2212 by 1659 pixels; portable fundus photograph.
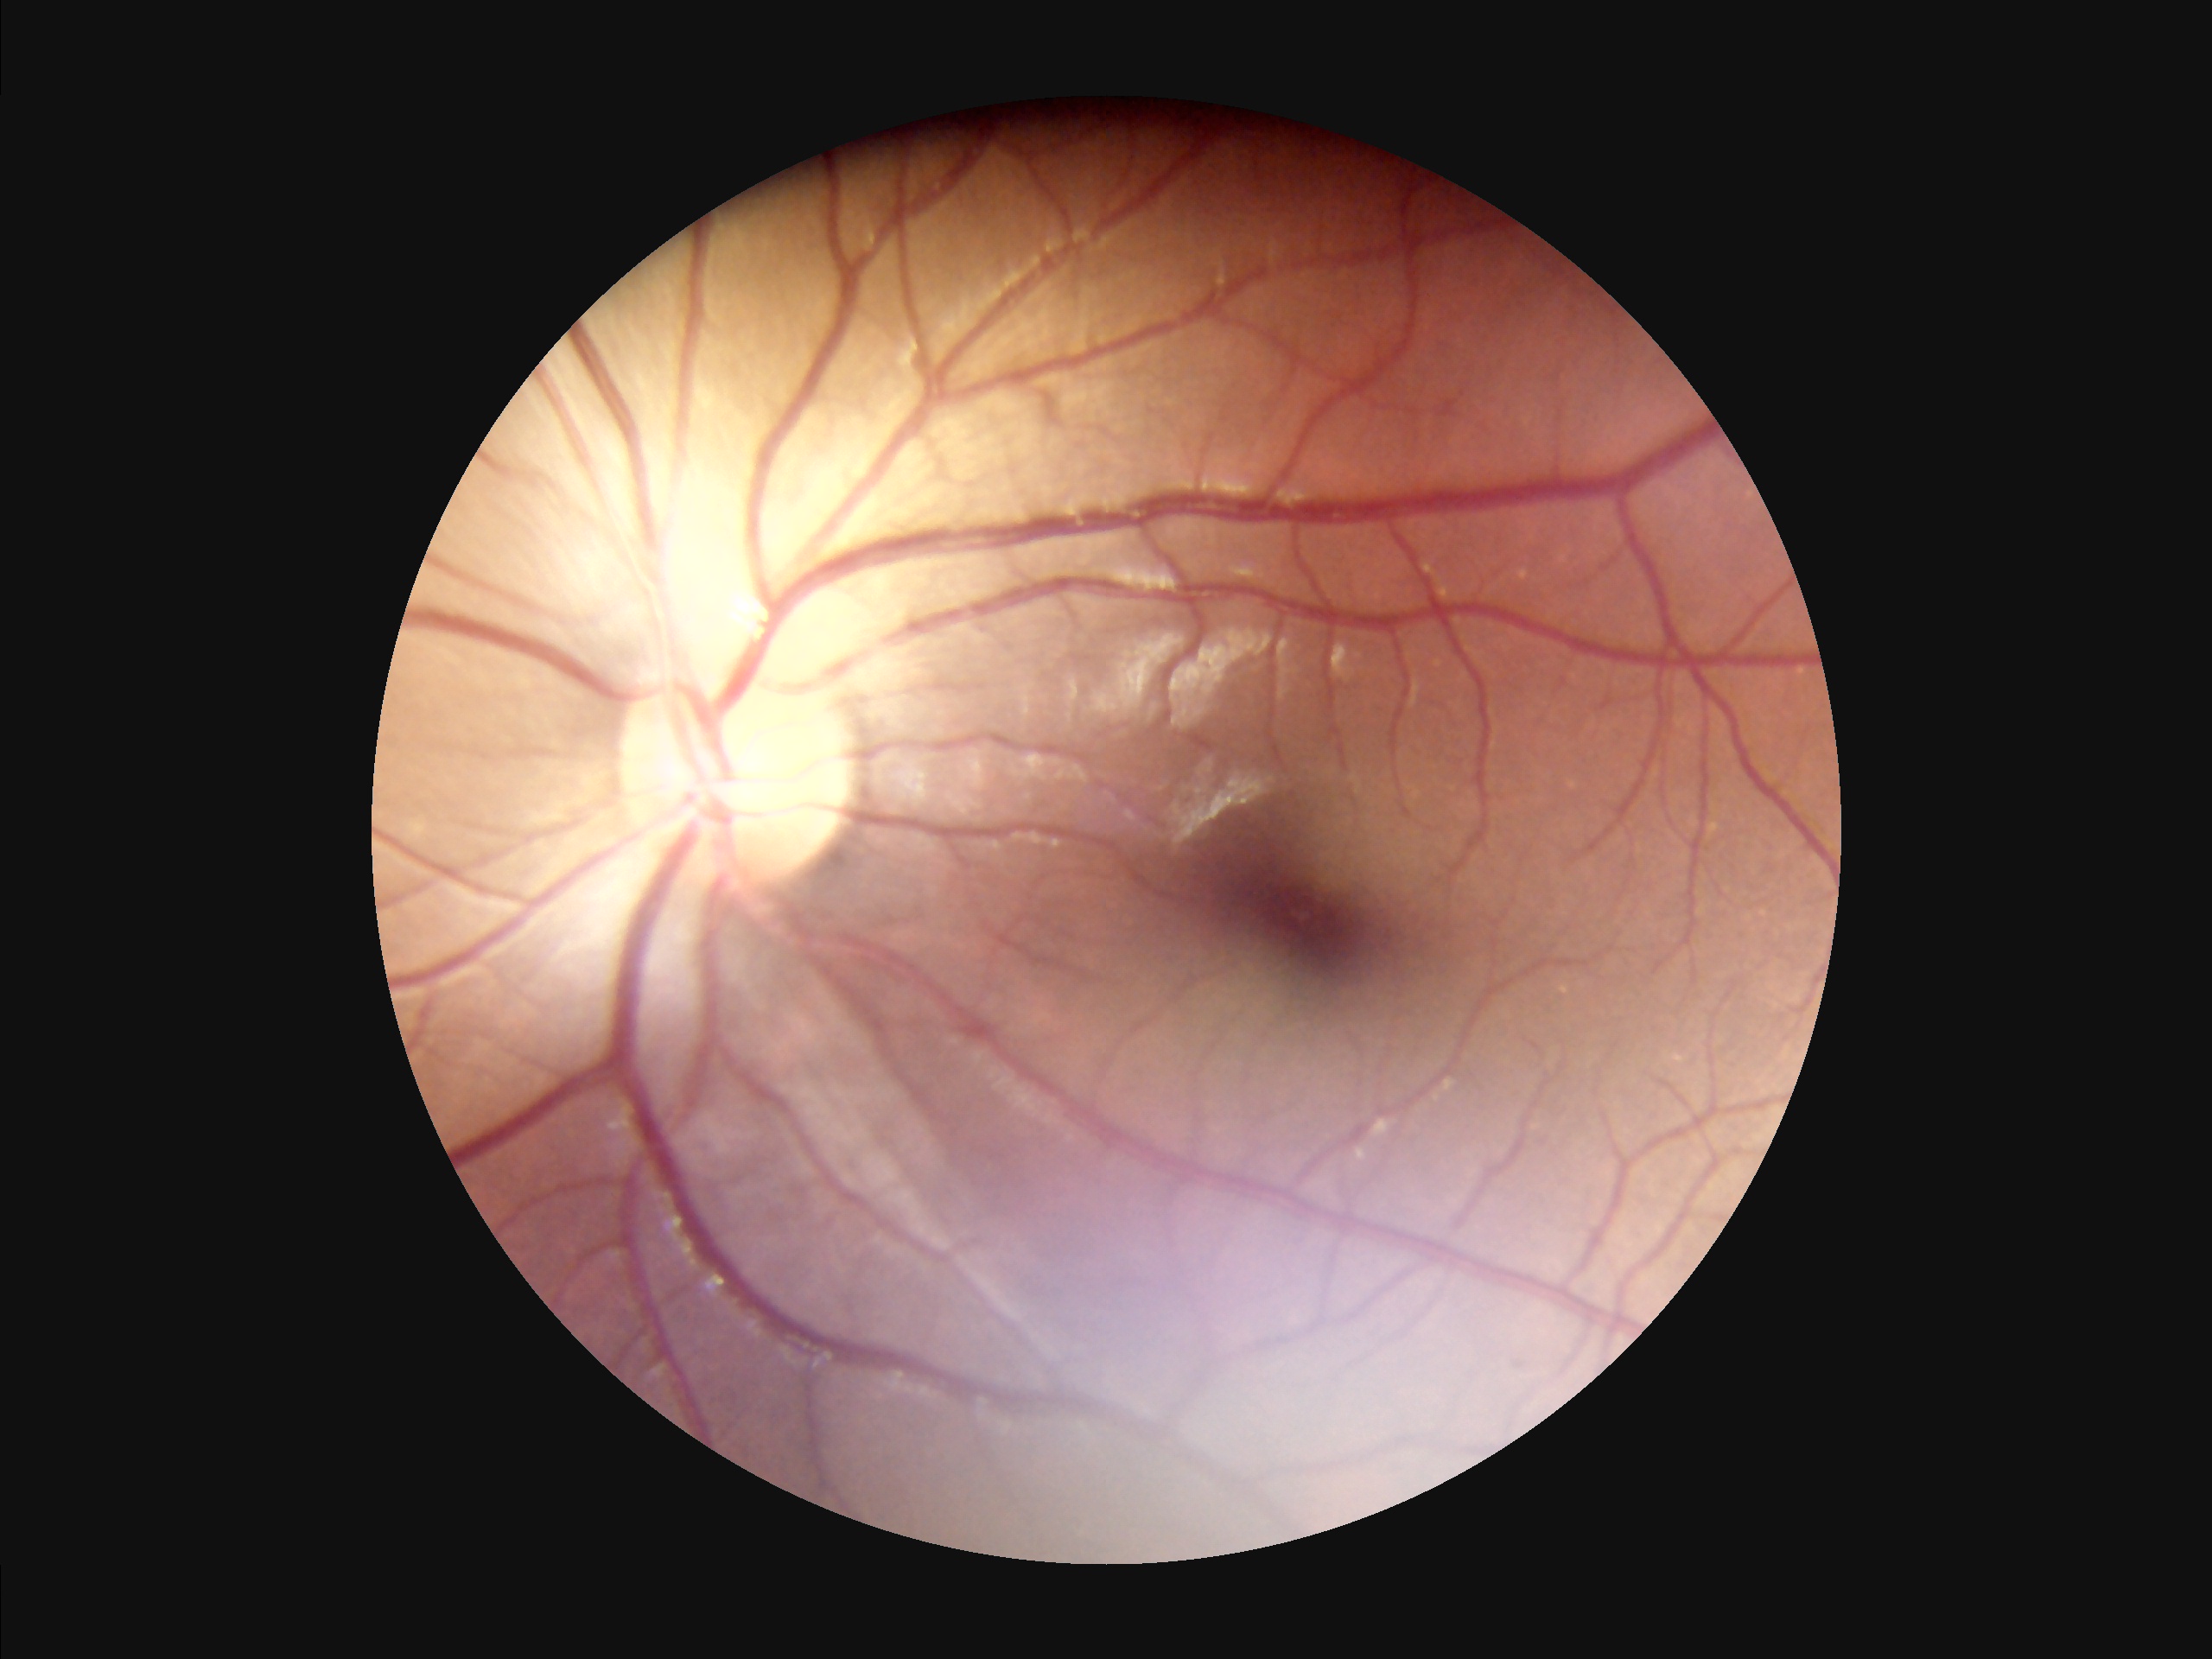 Overall quality is good and the image is gradable.
The image is clear.
Vessels and details are readily distinguishable.
Illumination is even.